45° field of view · nonmydriatic · camera: NIDEK AFC-230 · 848 x 848 pixels · color fundus image: 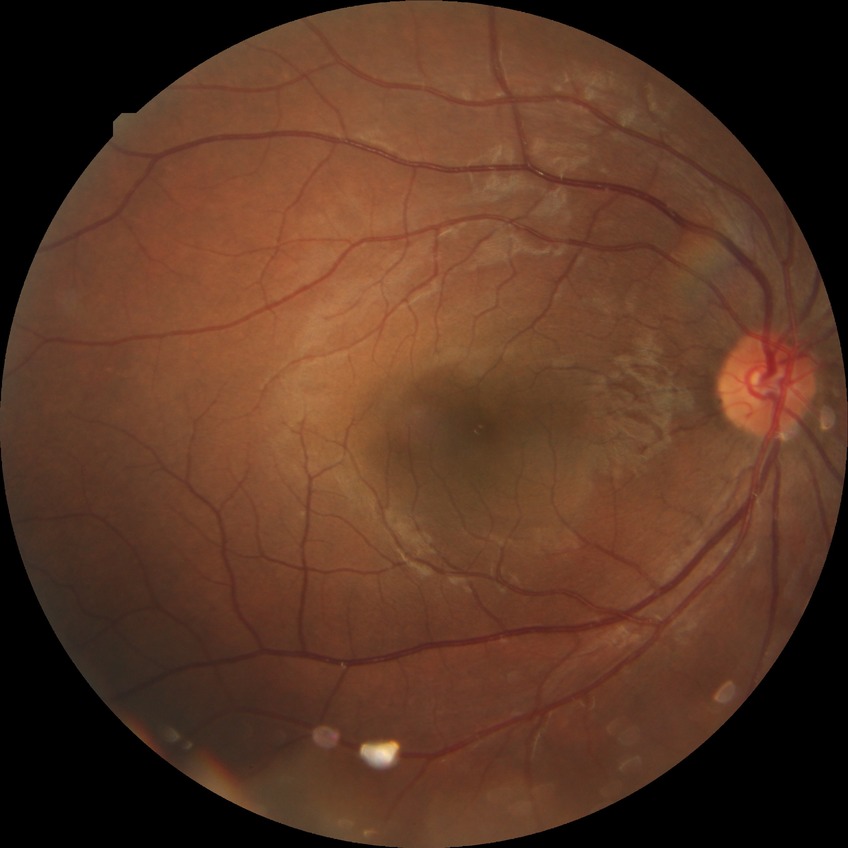

Retinopathy grade: no diabetic retinopathy.